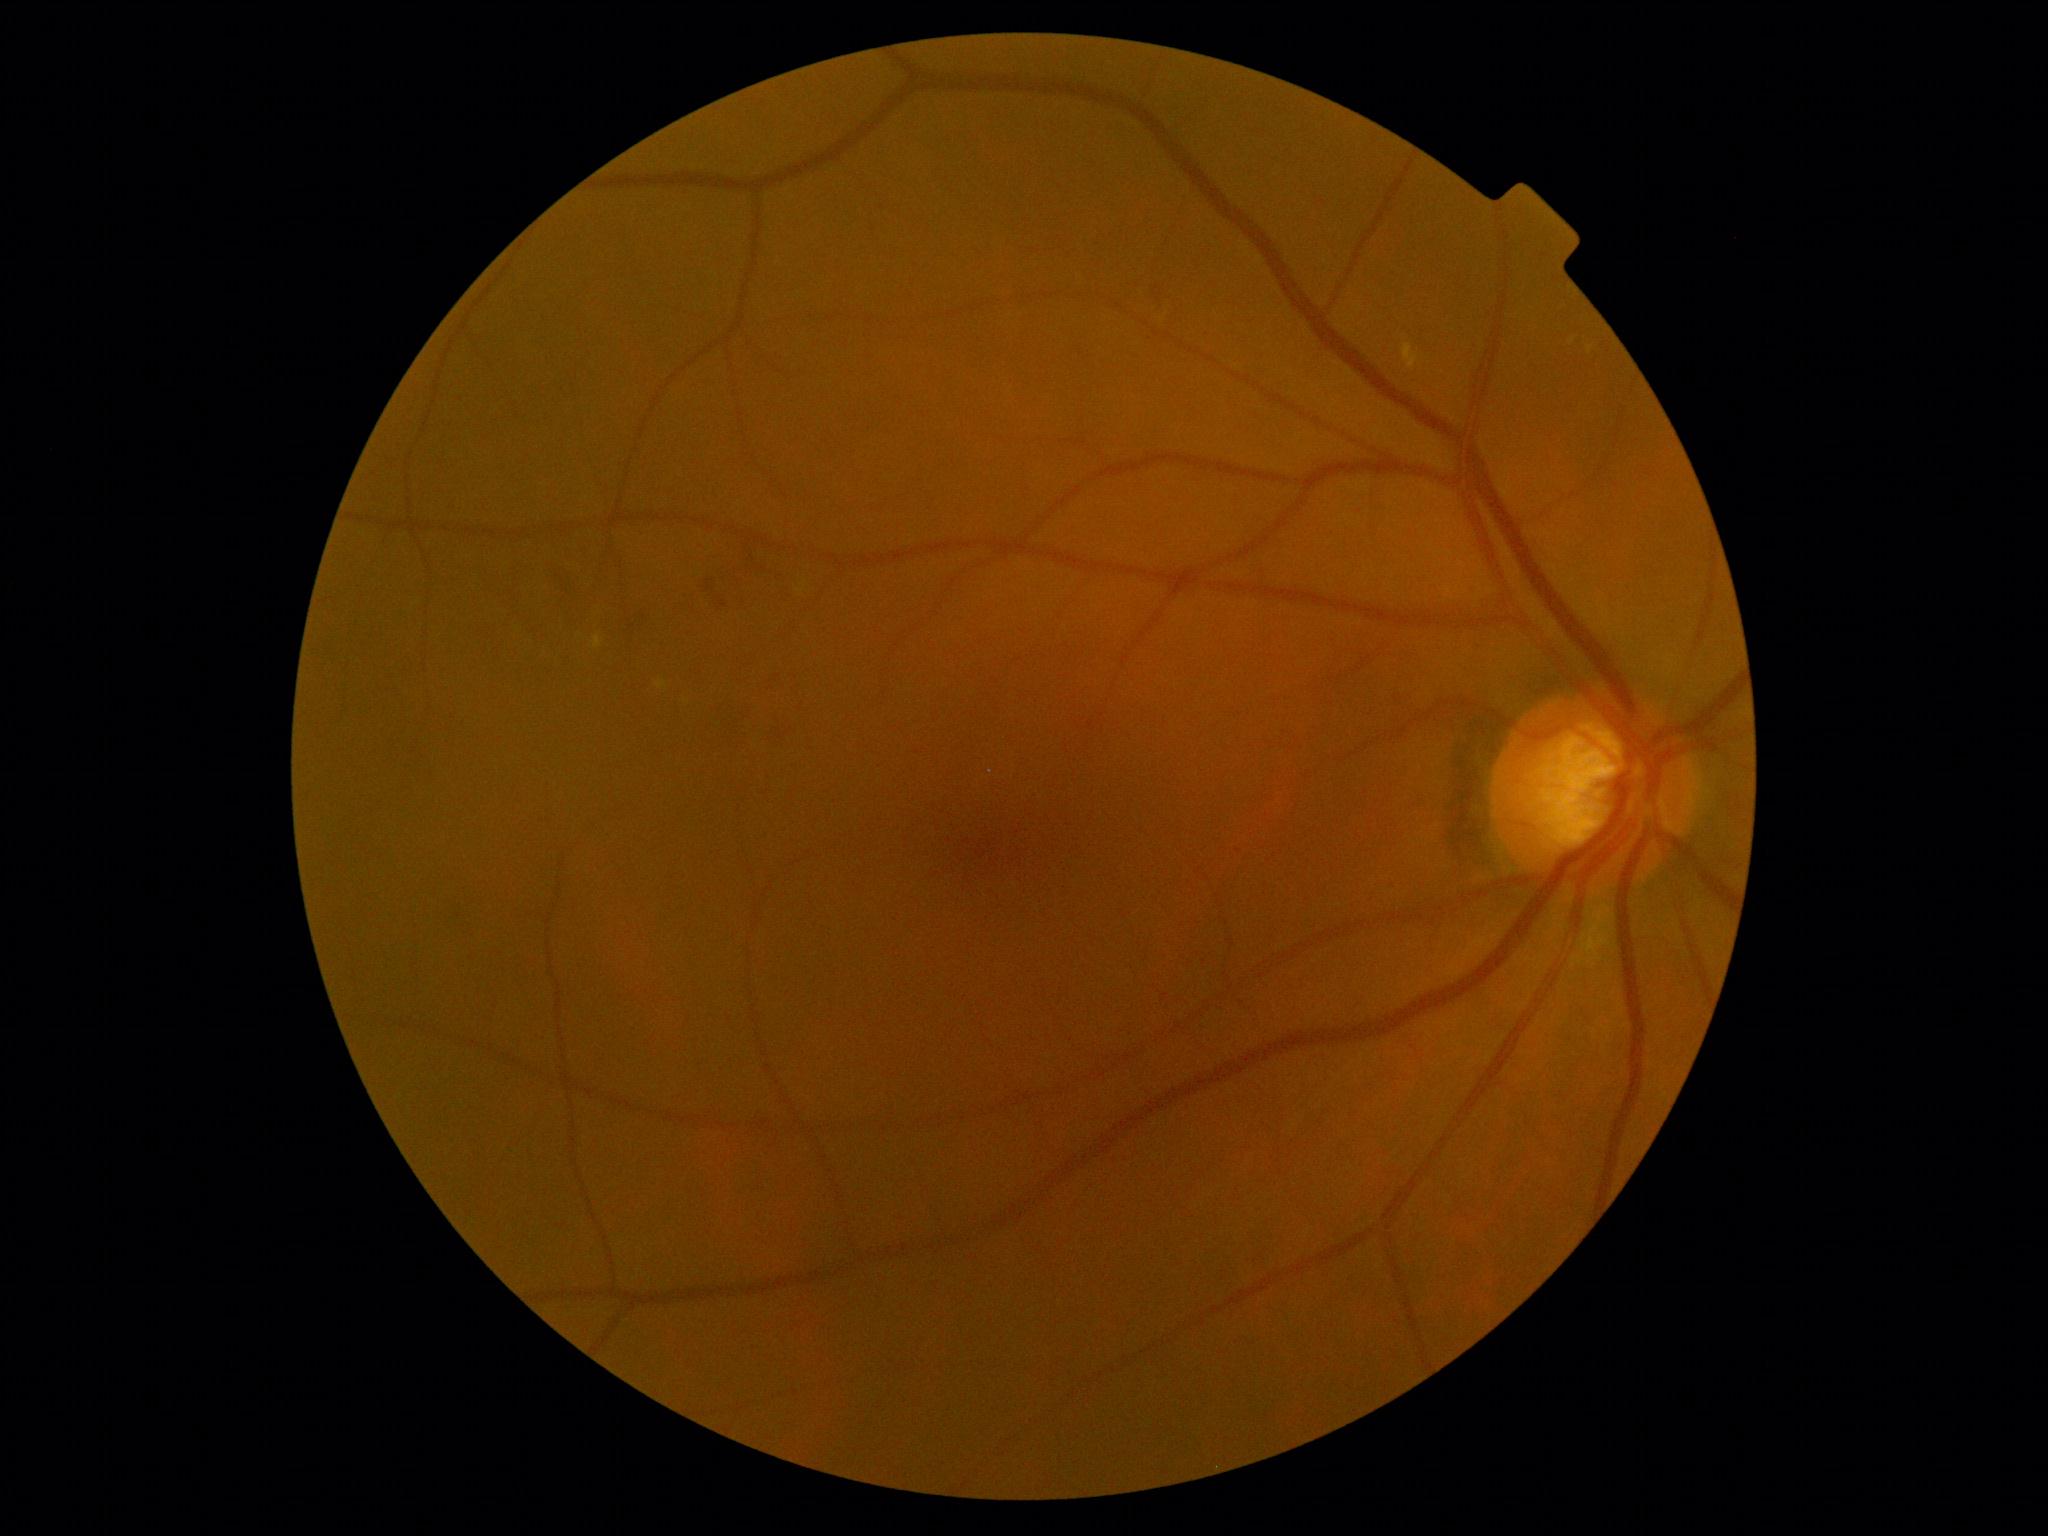

Diabetic retinopathy grade: moderate non-proliferative diabetic retinopathy (2). DR class: non-proliferative diabetic retinopathy.